Wide-field fundus photograph from neonatal ROP screening:
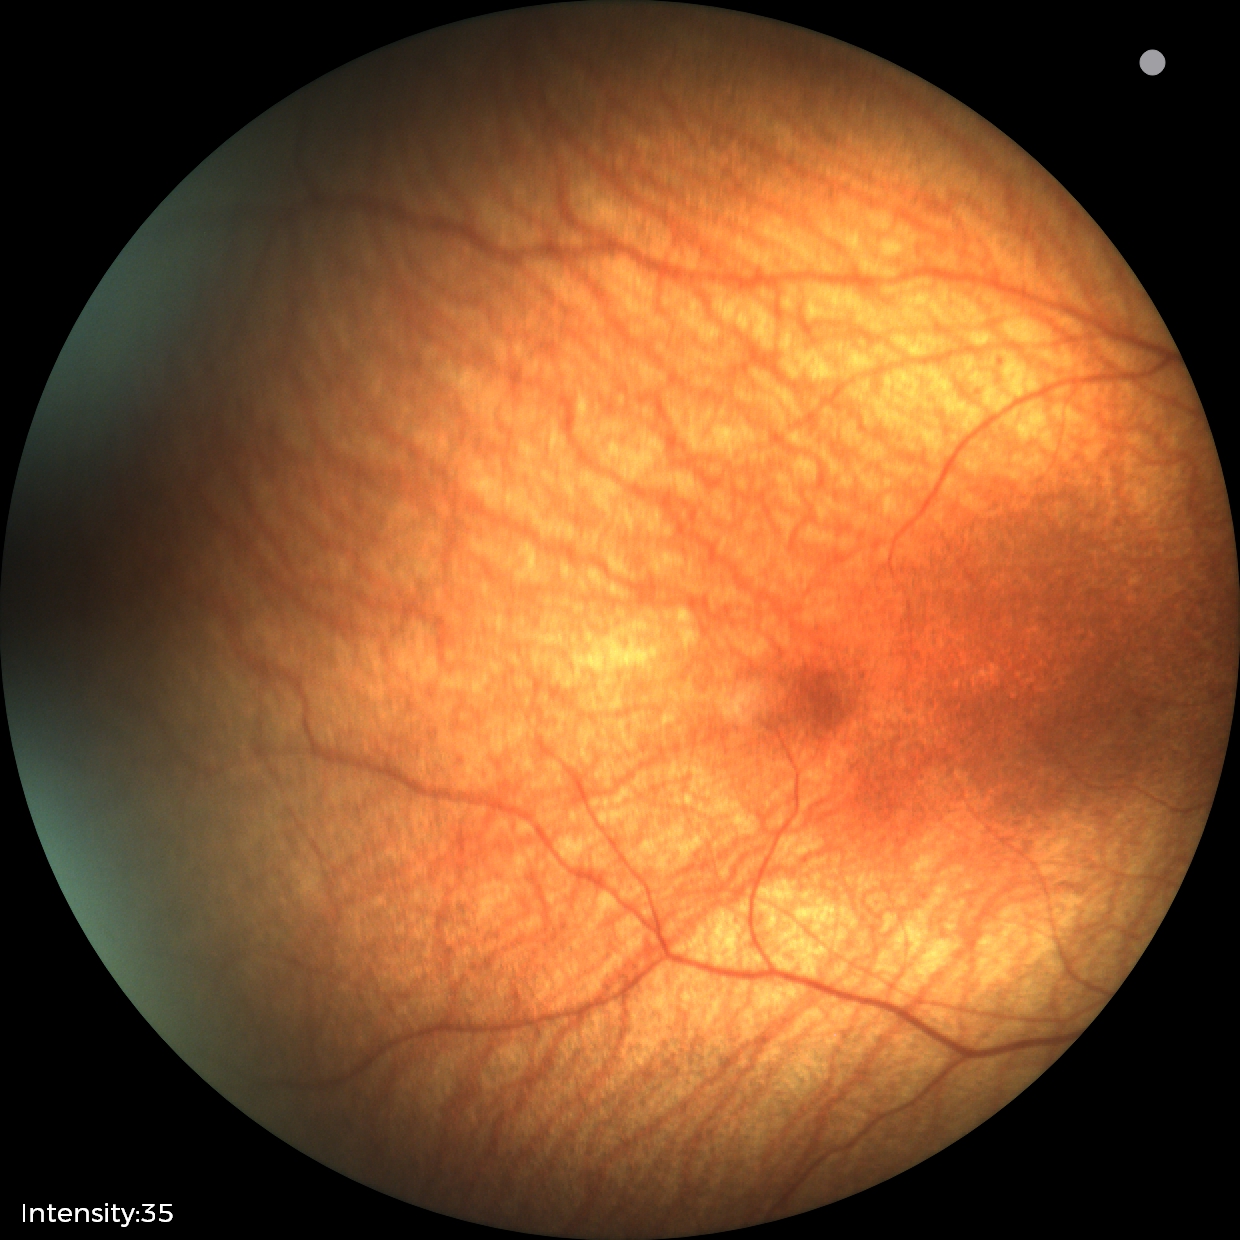

No retinal pathology identified on screening.